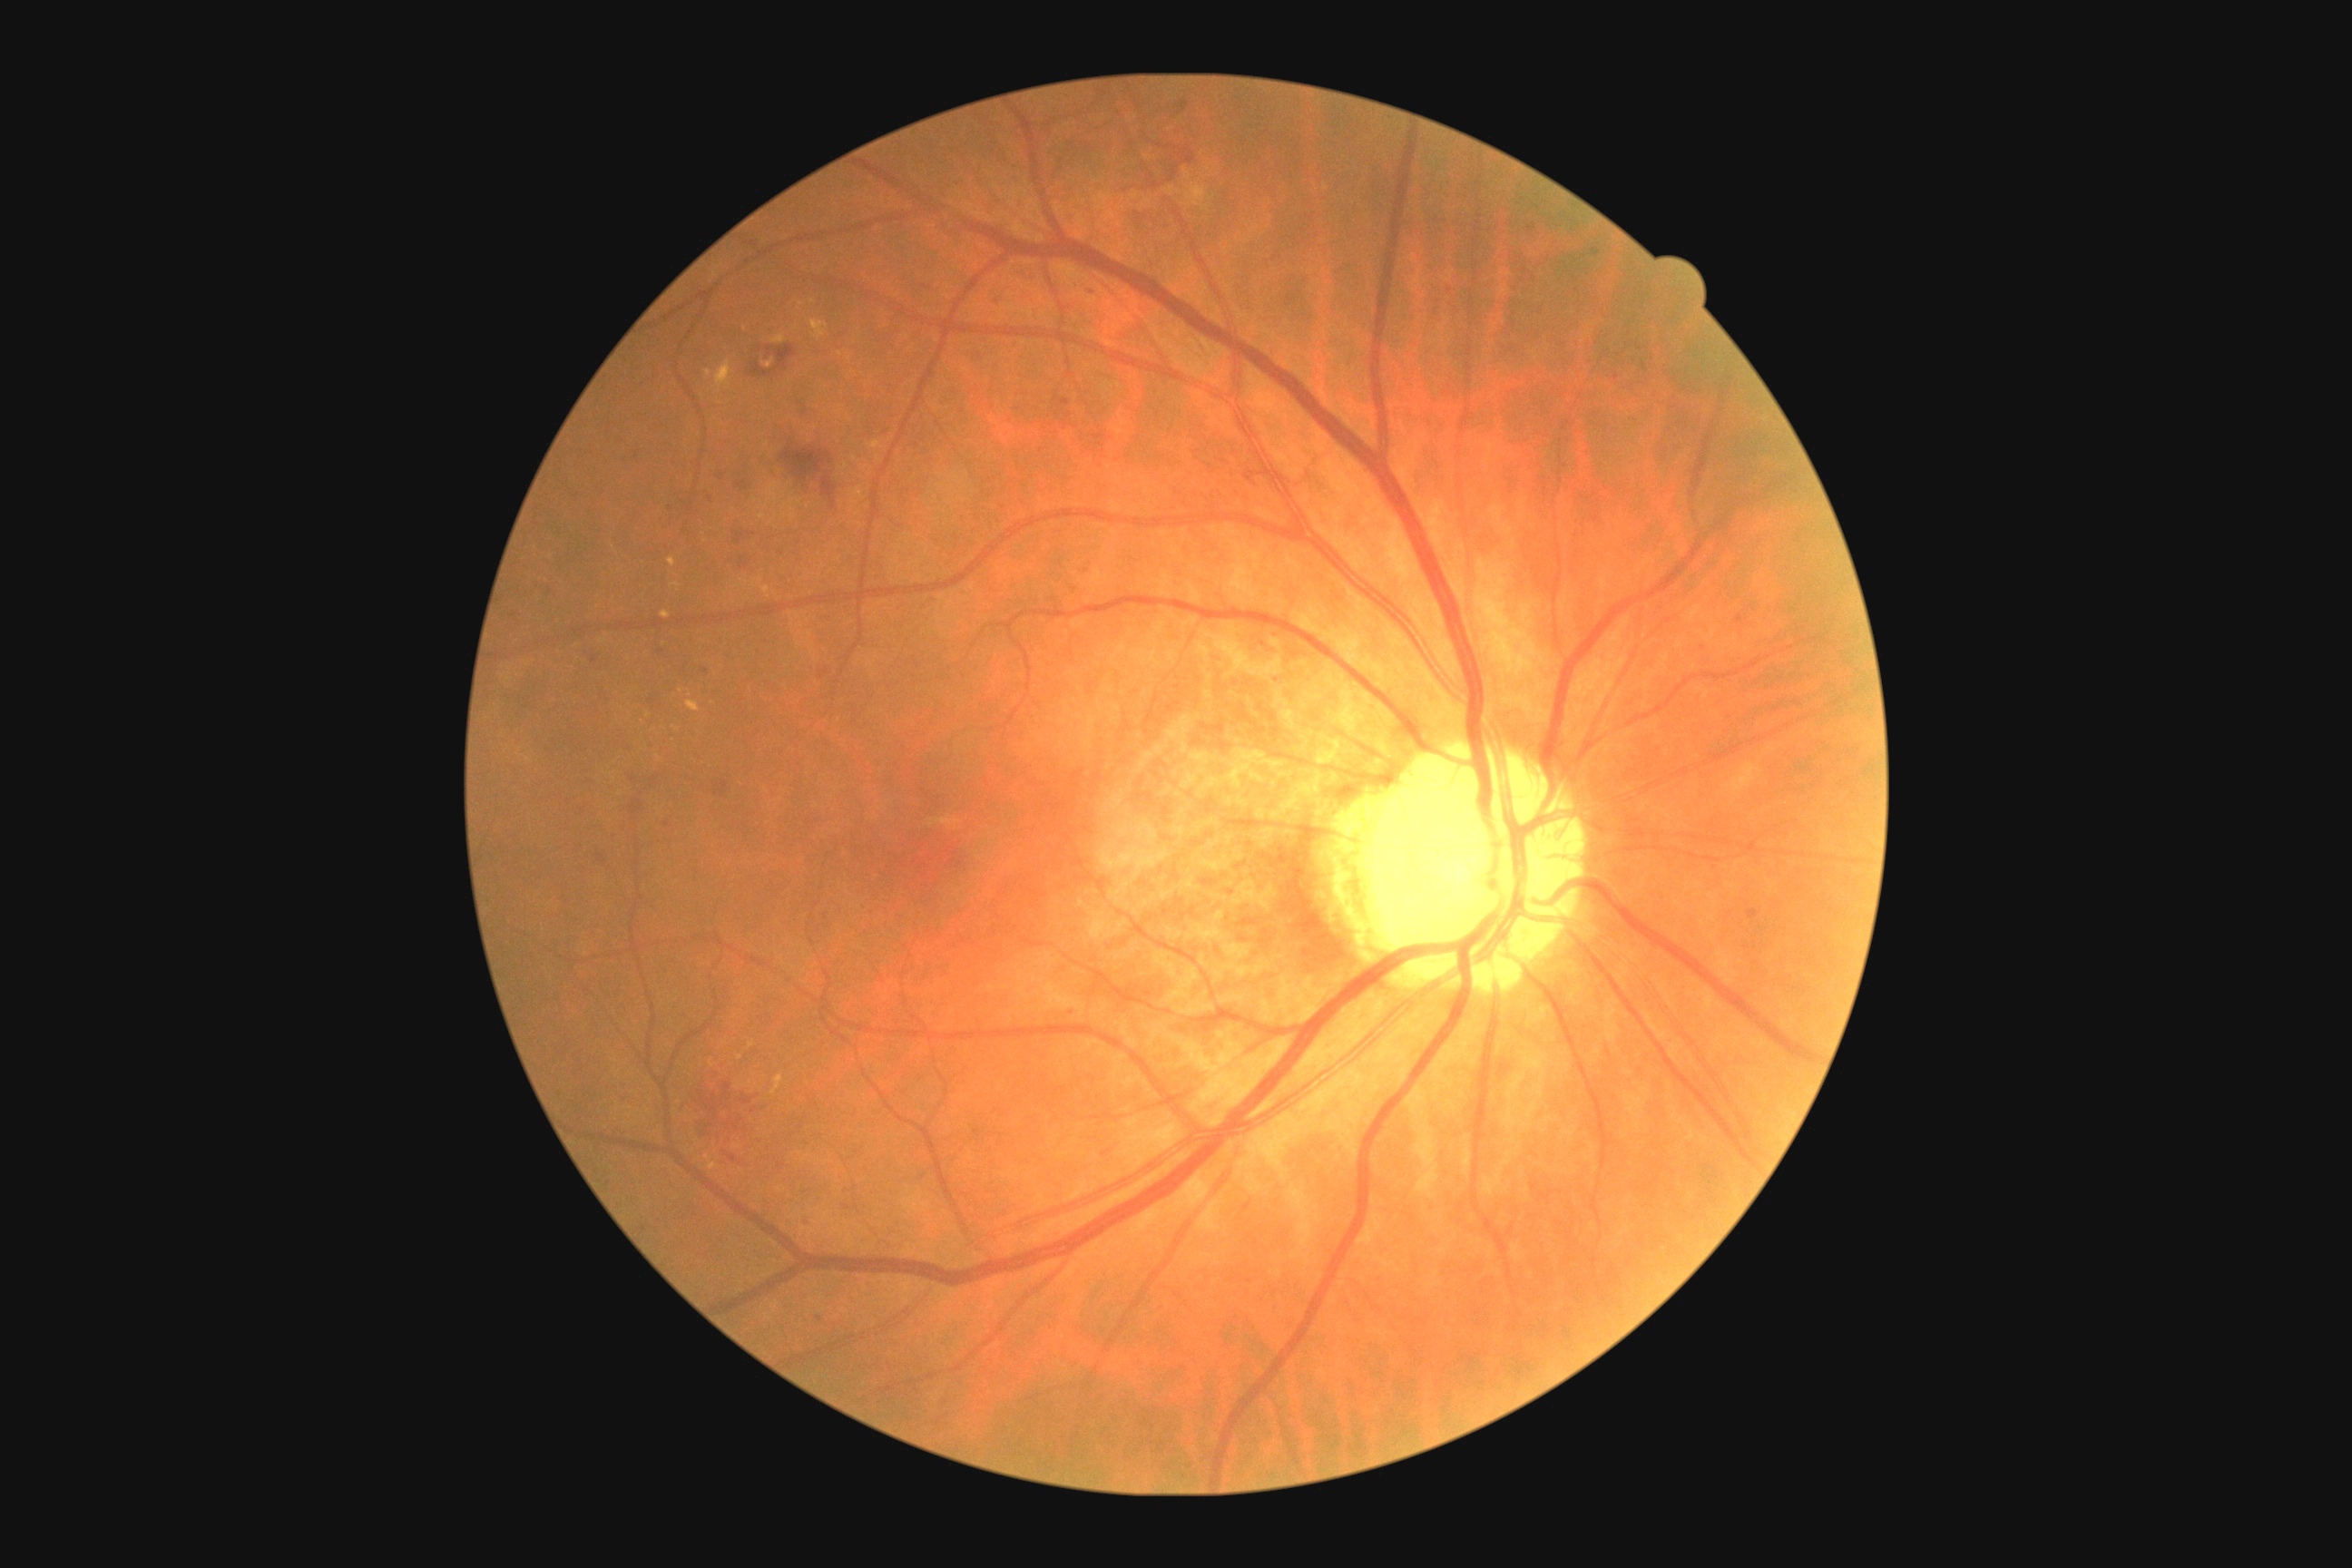
DR severity@2/4 — more than just microaneurysms but less than severe NPDR.